ONH-centered crop from a color fundus image:
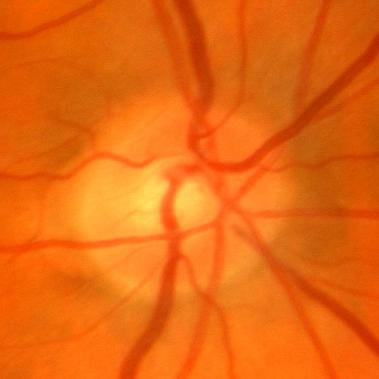
No evidence of glaucoma.